Infant wide-field retinal image; image size 1240x1240: 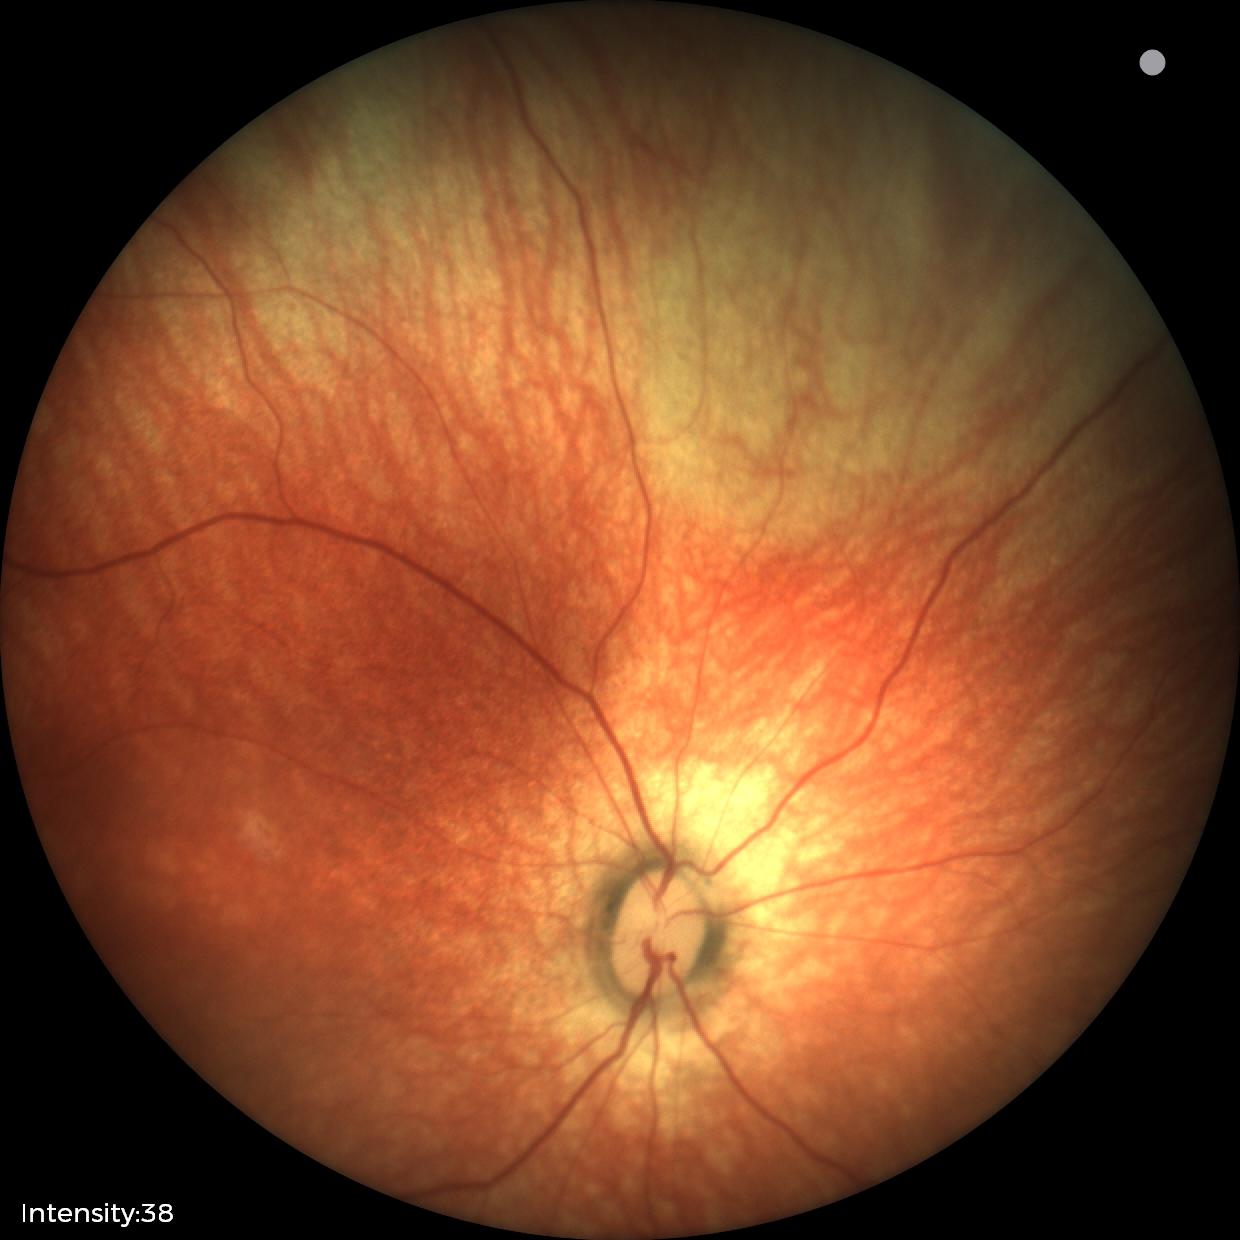 Screening: physiological retinal finding.